Acquired with a NIDEK AFC-230.
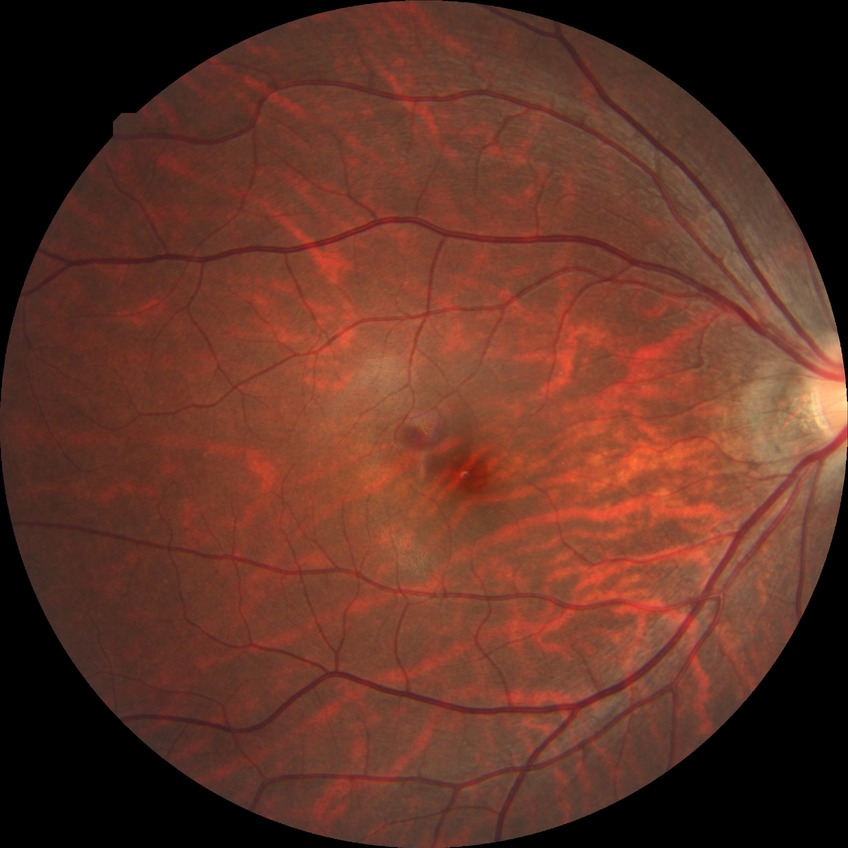 Davis grade: NDR.
No diabetic retinal disease findings.